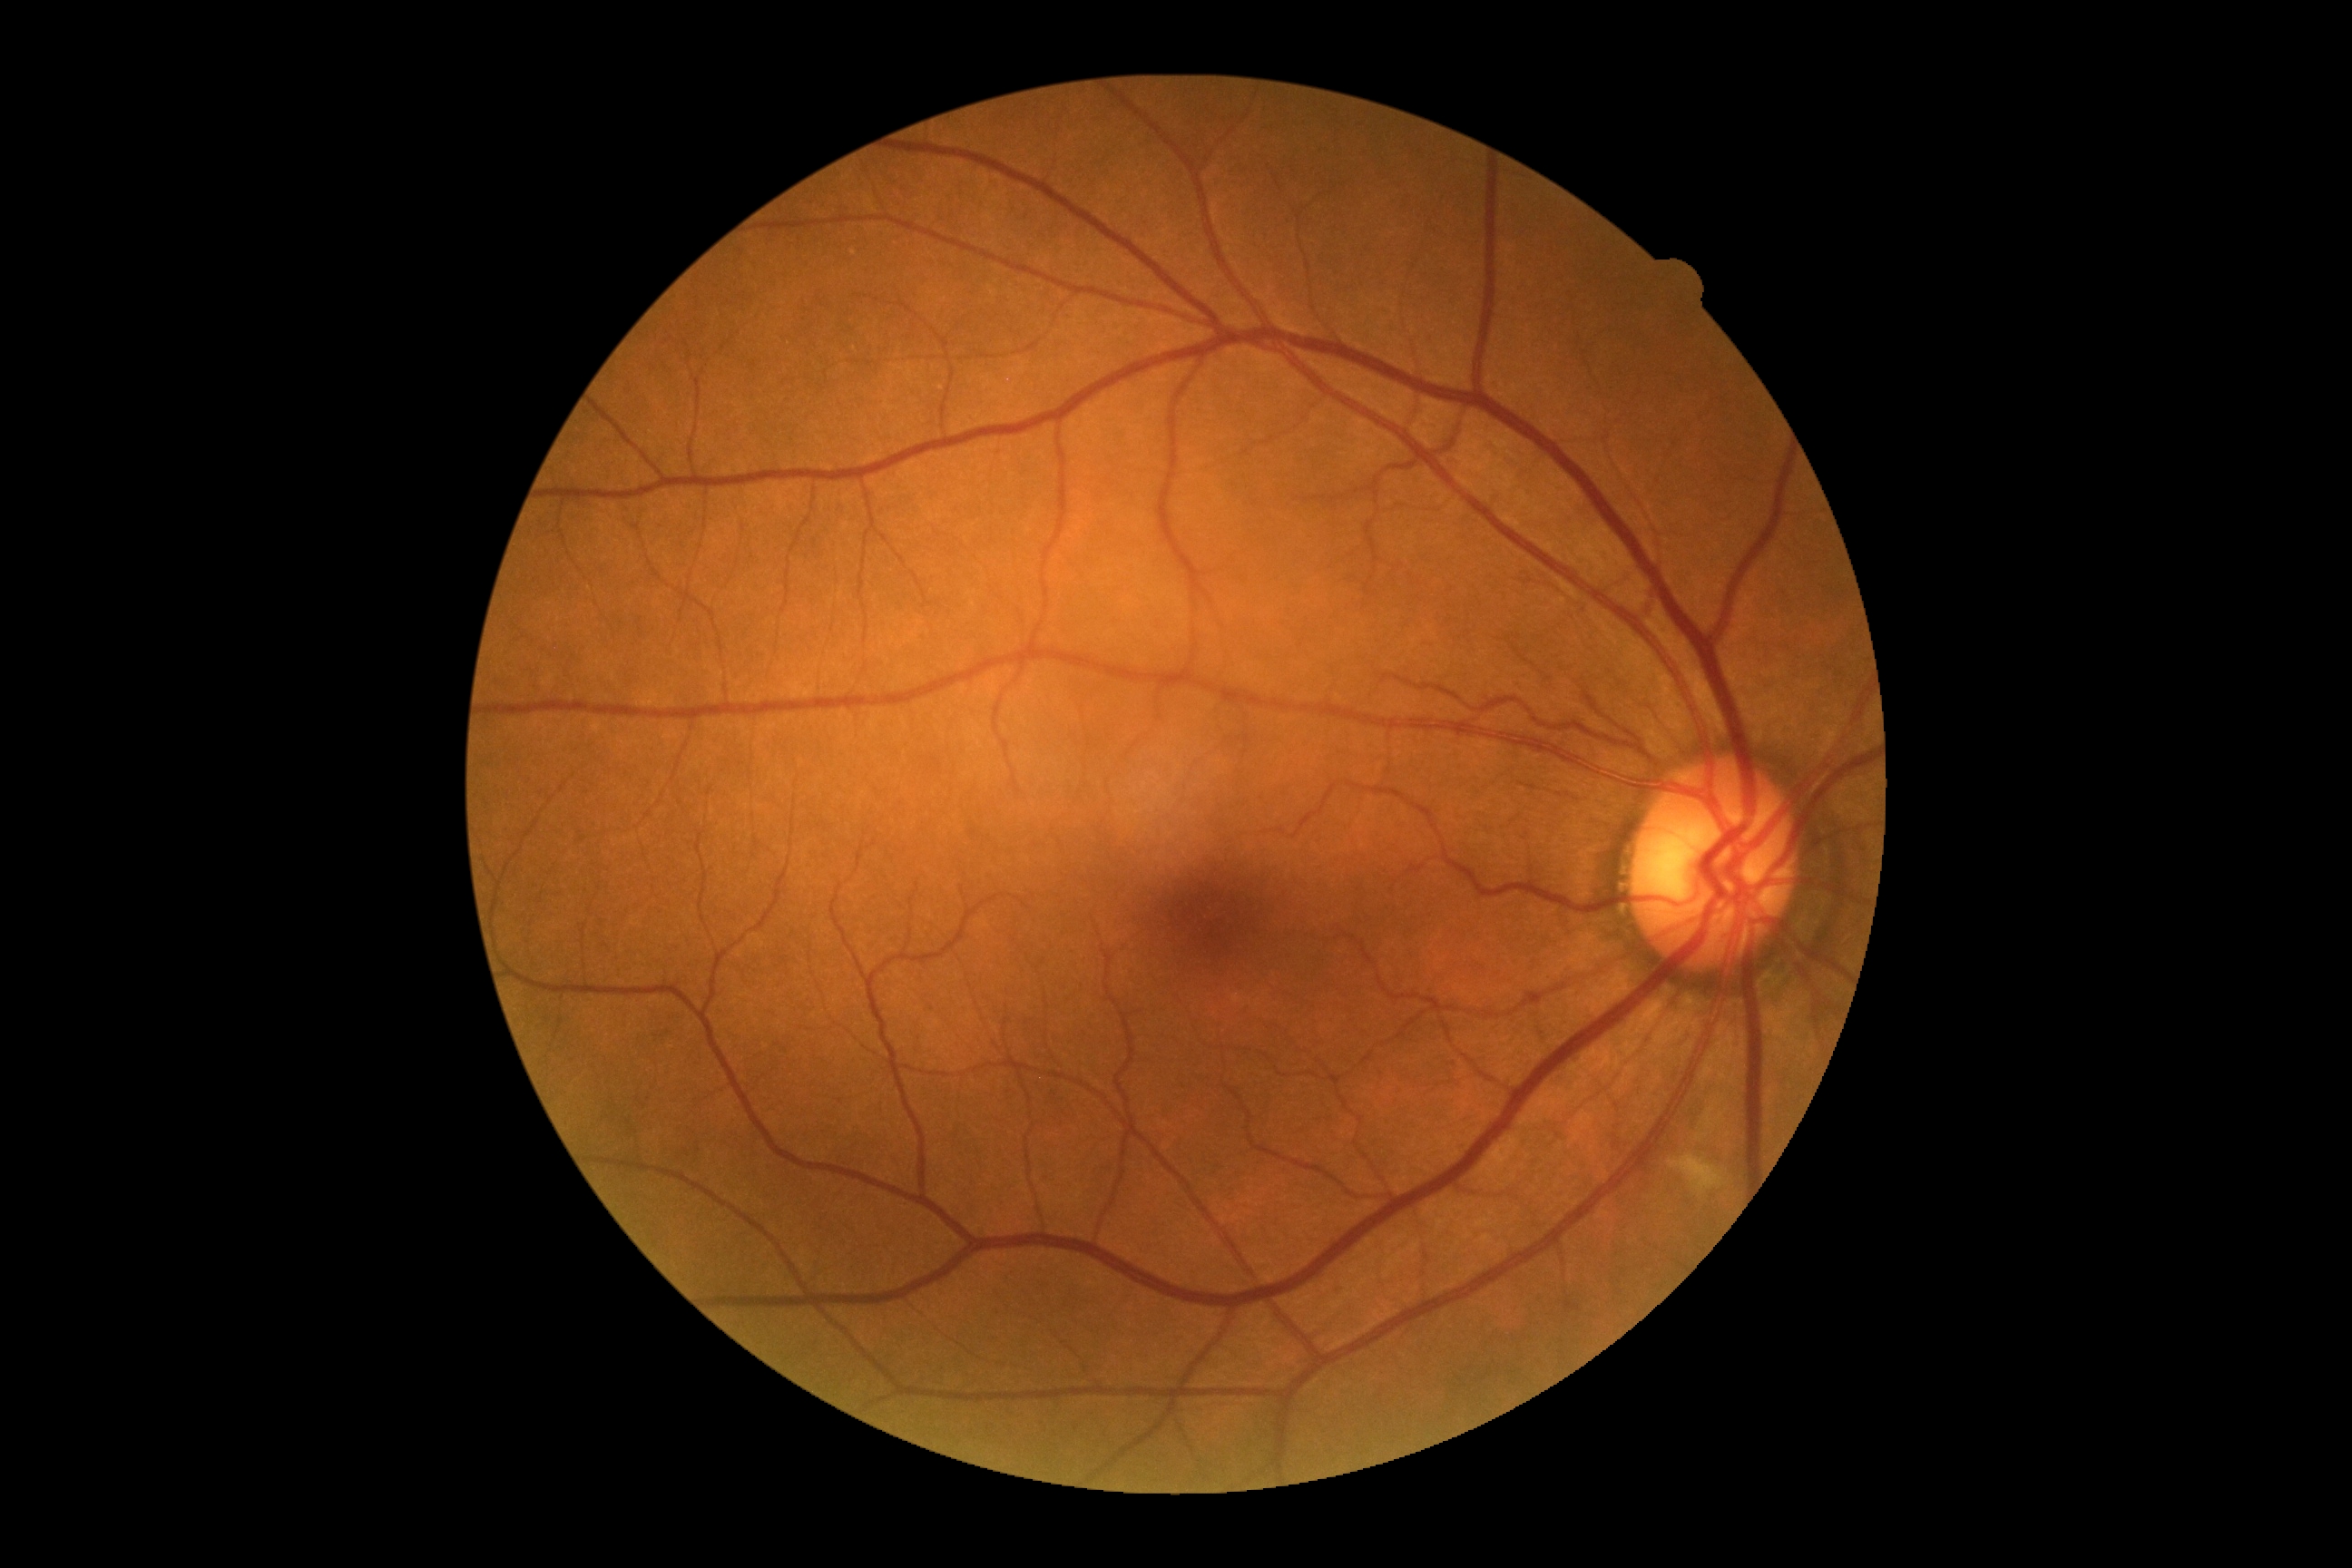

DR severity: moderate NPDR (grade 2) — more than just microaneurysms but less than severe NPDR.